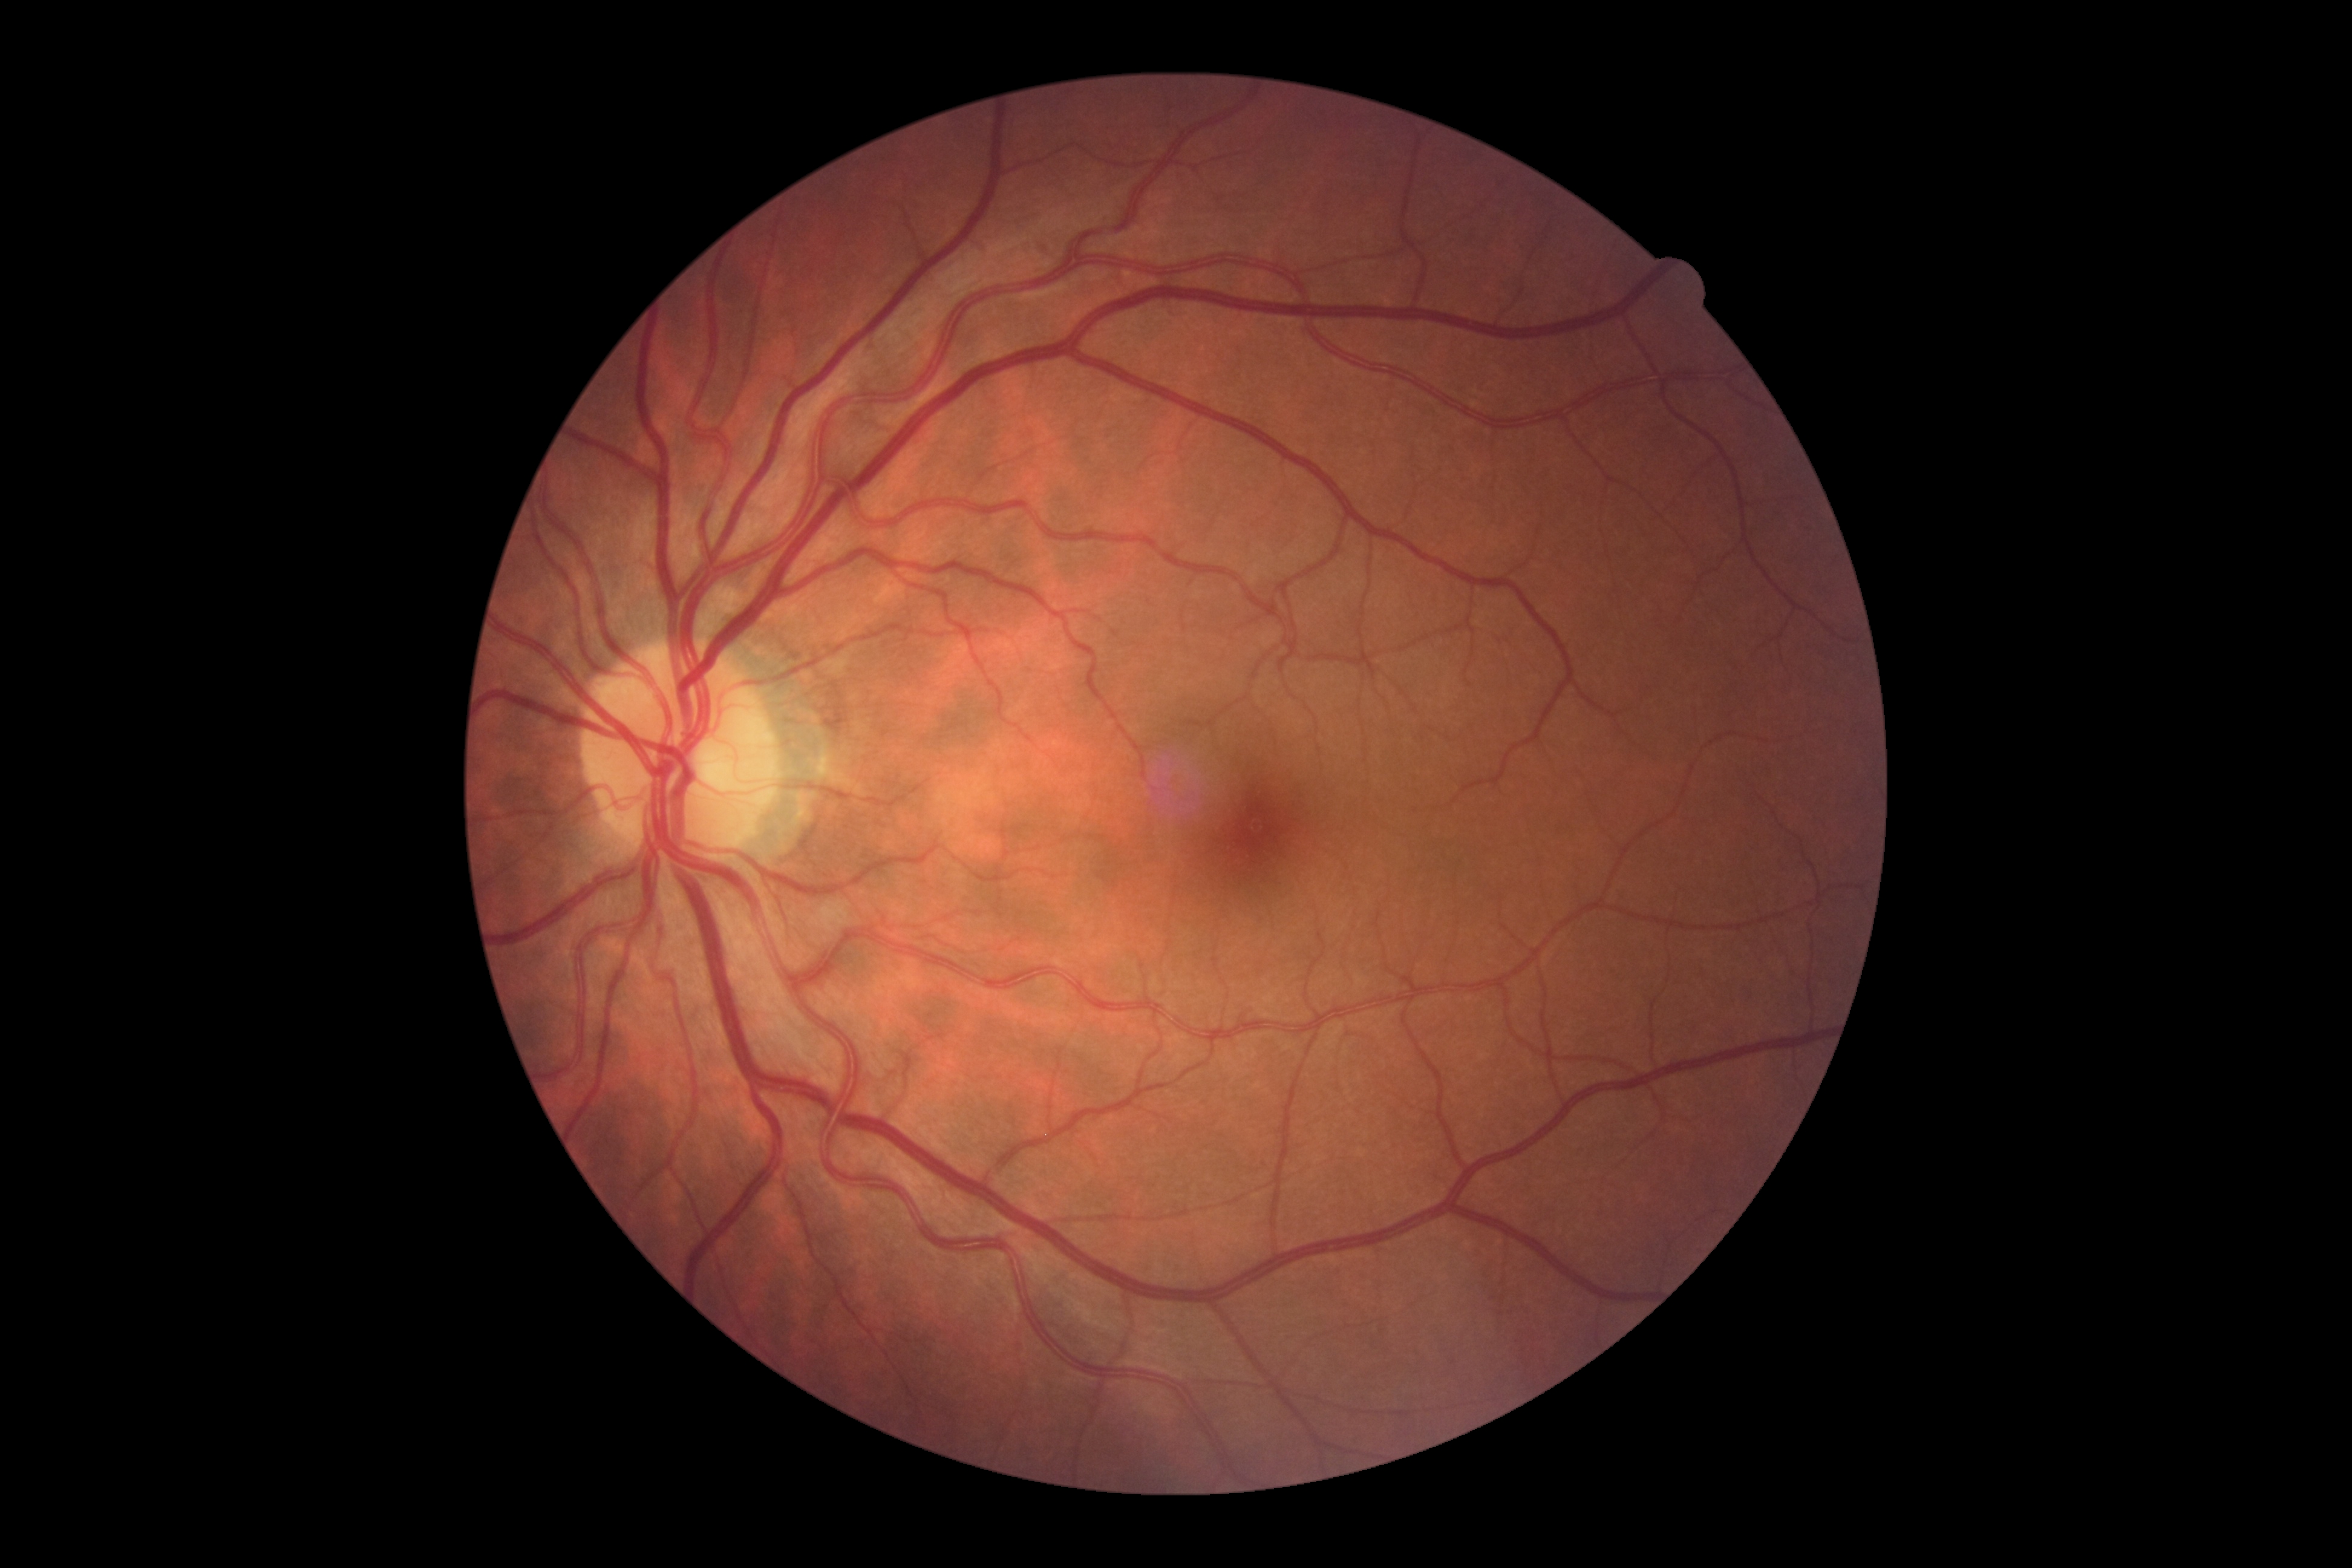
DR severity: no apparent retinopathy (grade 0).